2352x1568.
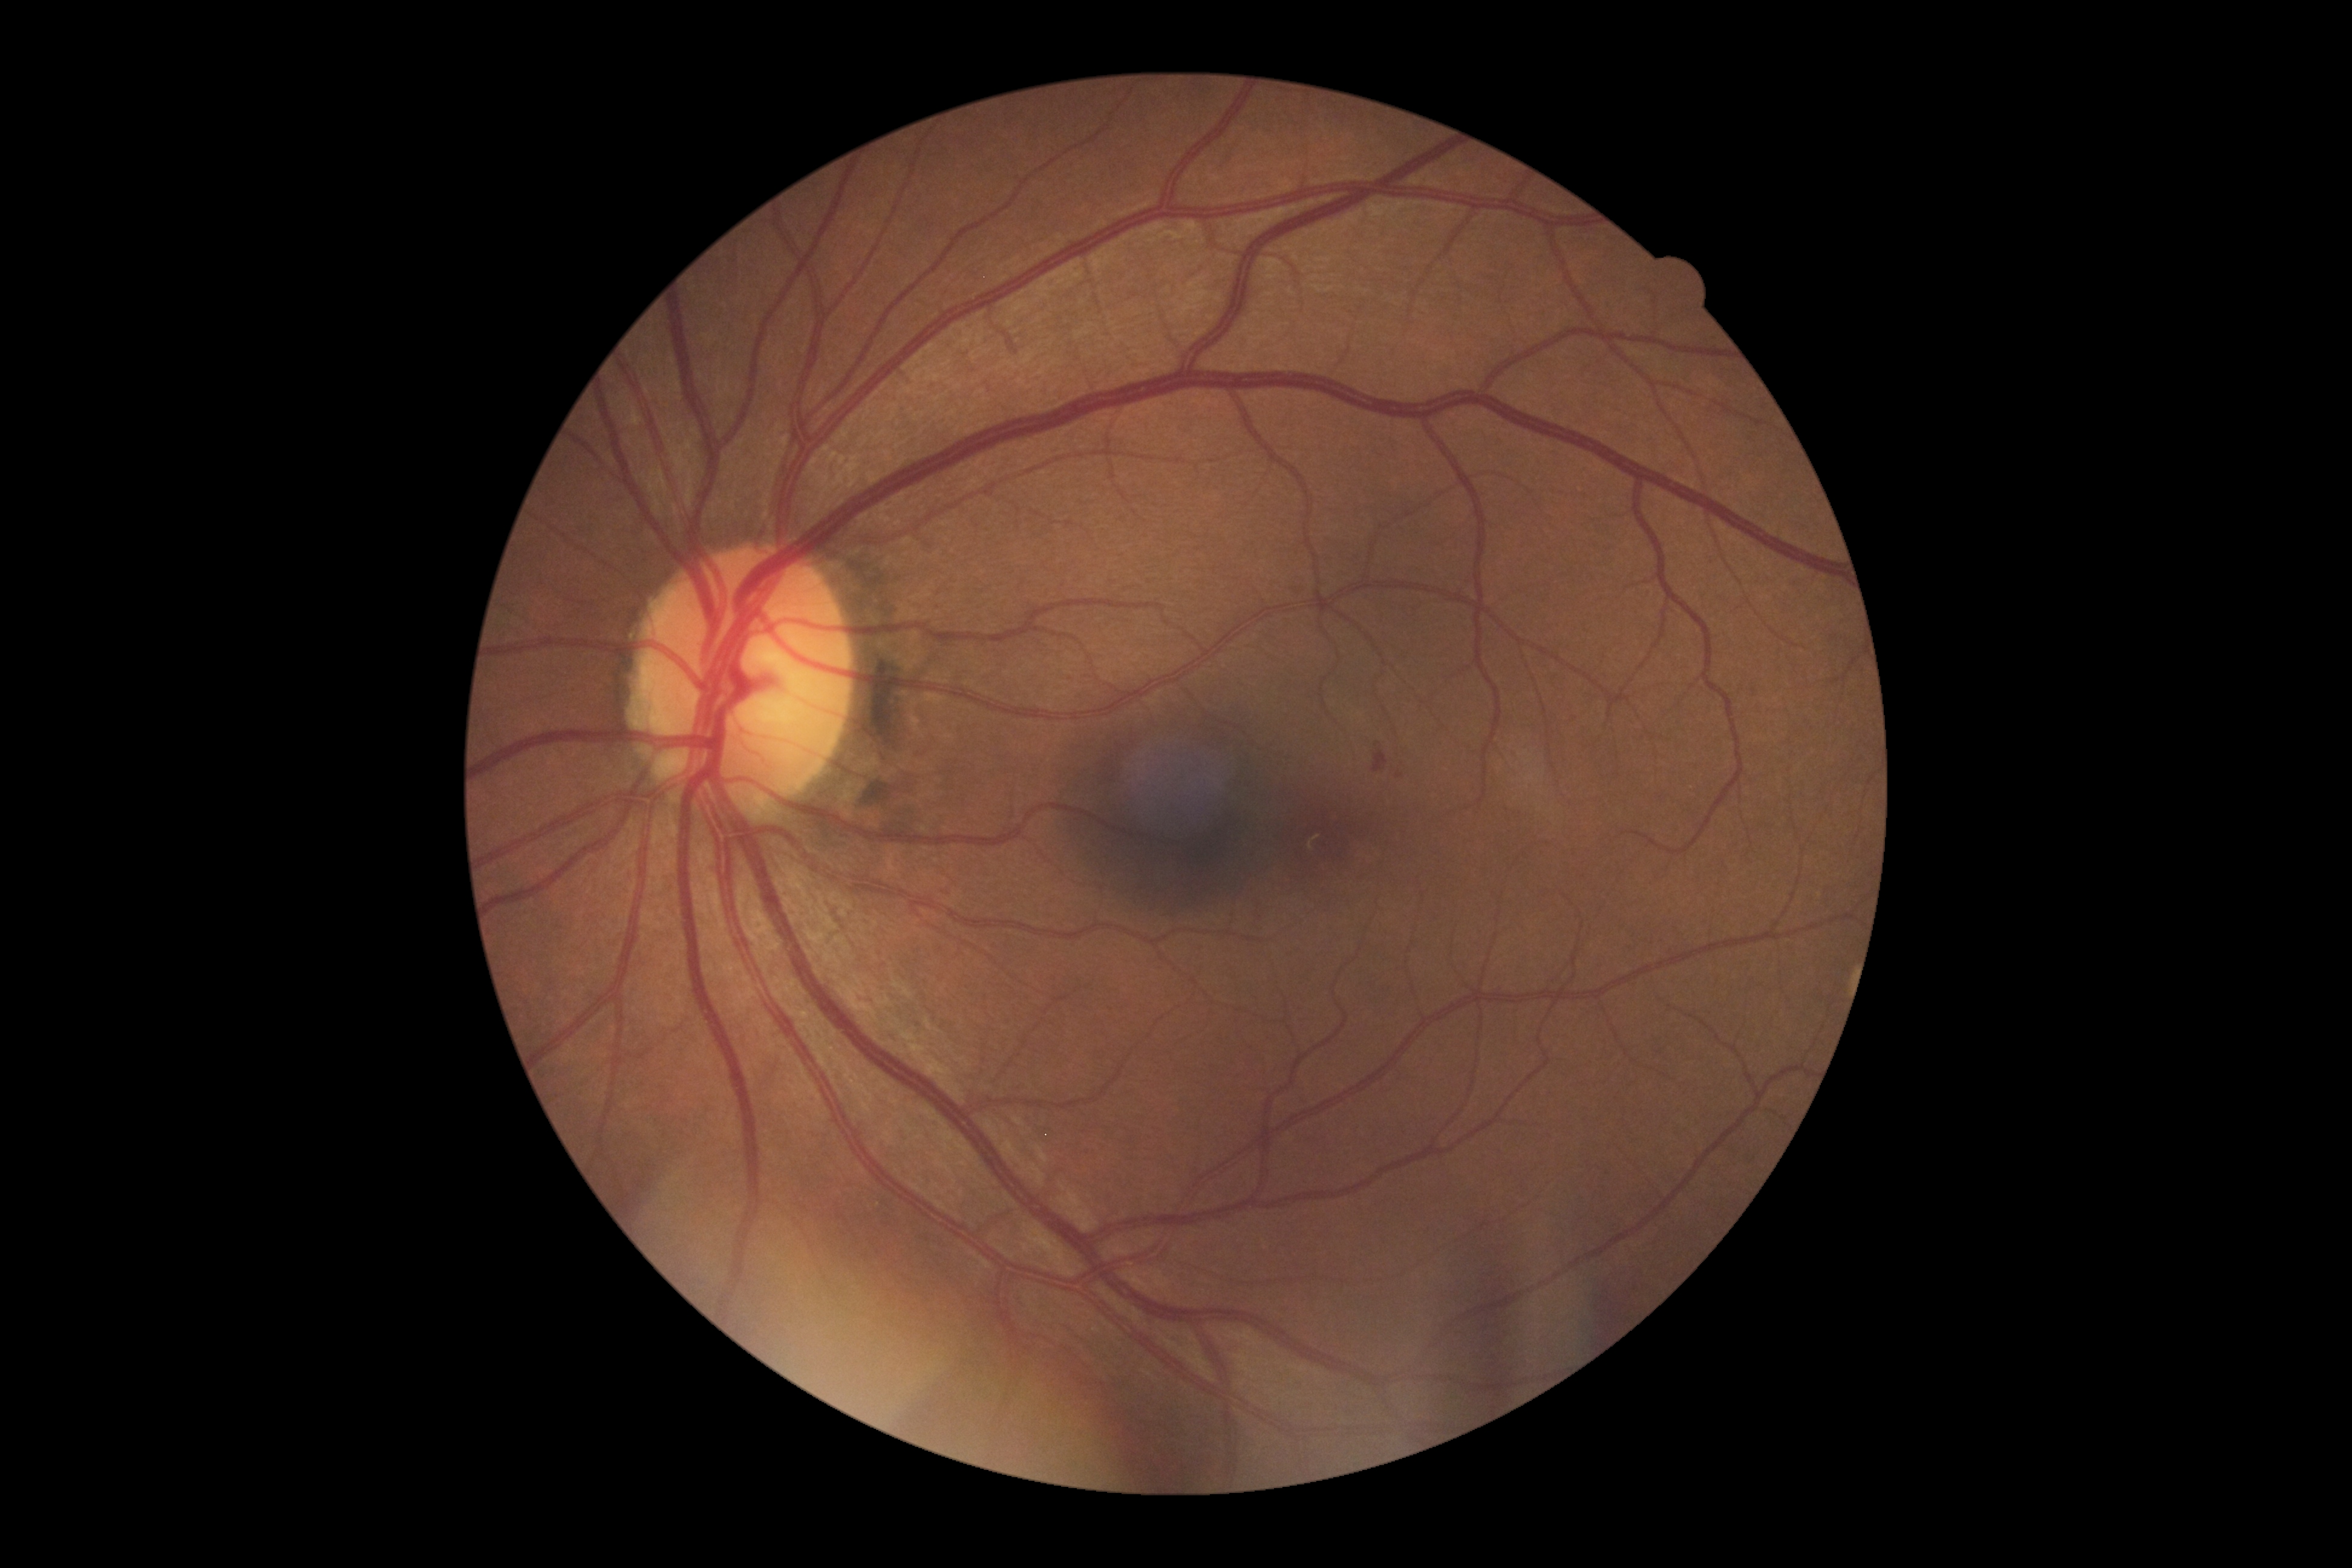 DR stage: 2/4 — more than just microaneurysms but less than severe NPDR, DR class: non-proliferative diabetic retinopathy.